848 x 848 pixels
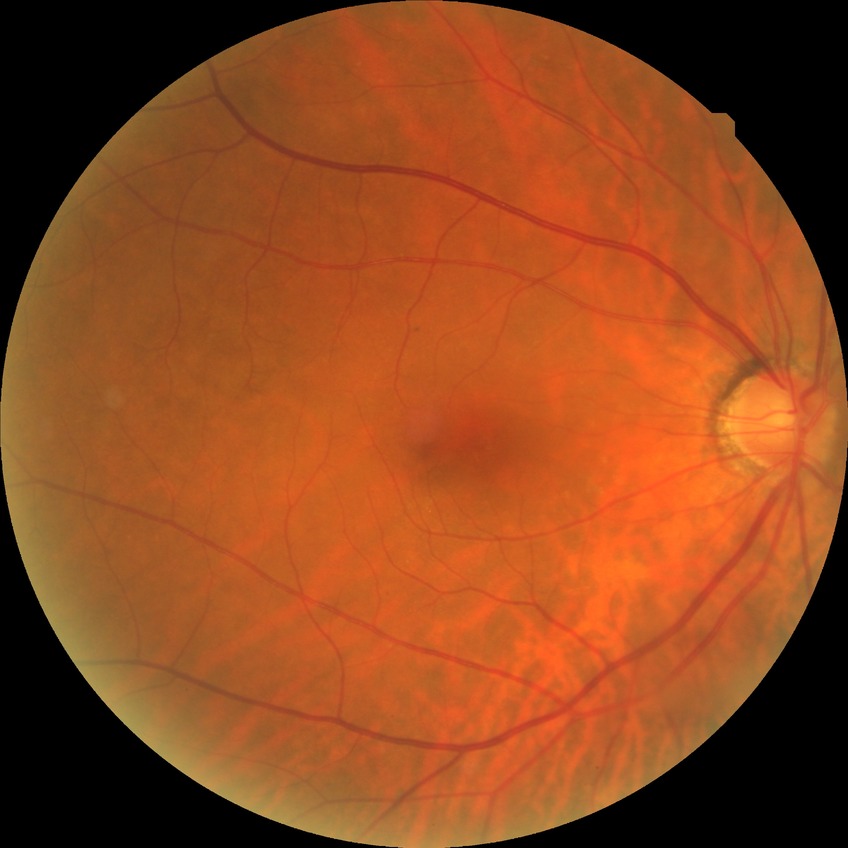 {"davis_grade": "no diabetic retinopathy"}